FOV: 45 degrees; image size 2352x1568 — 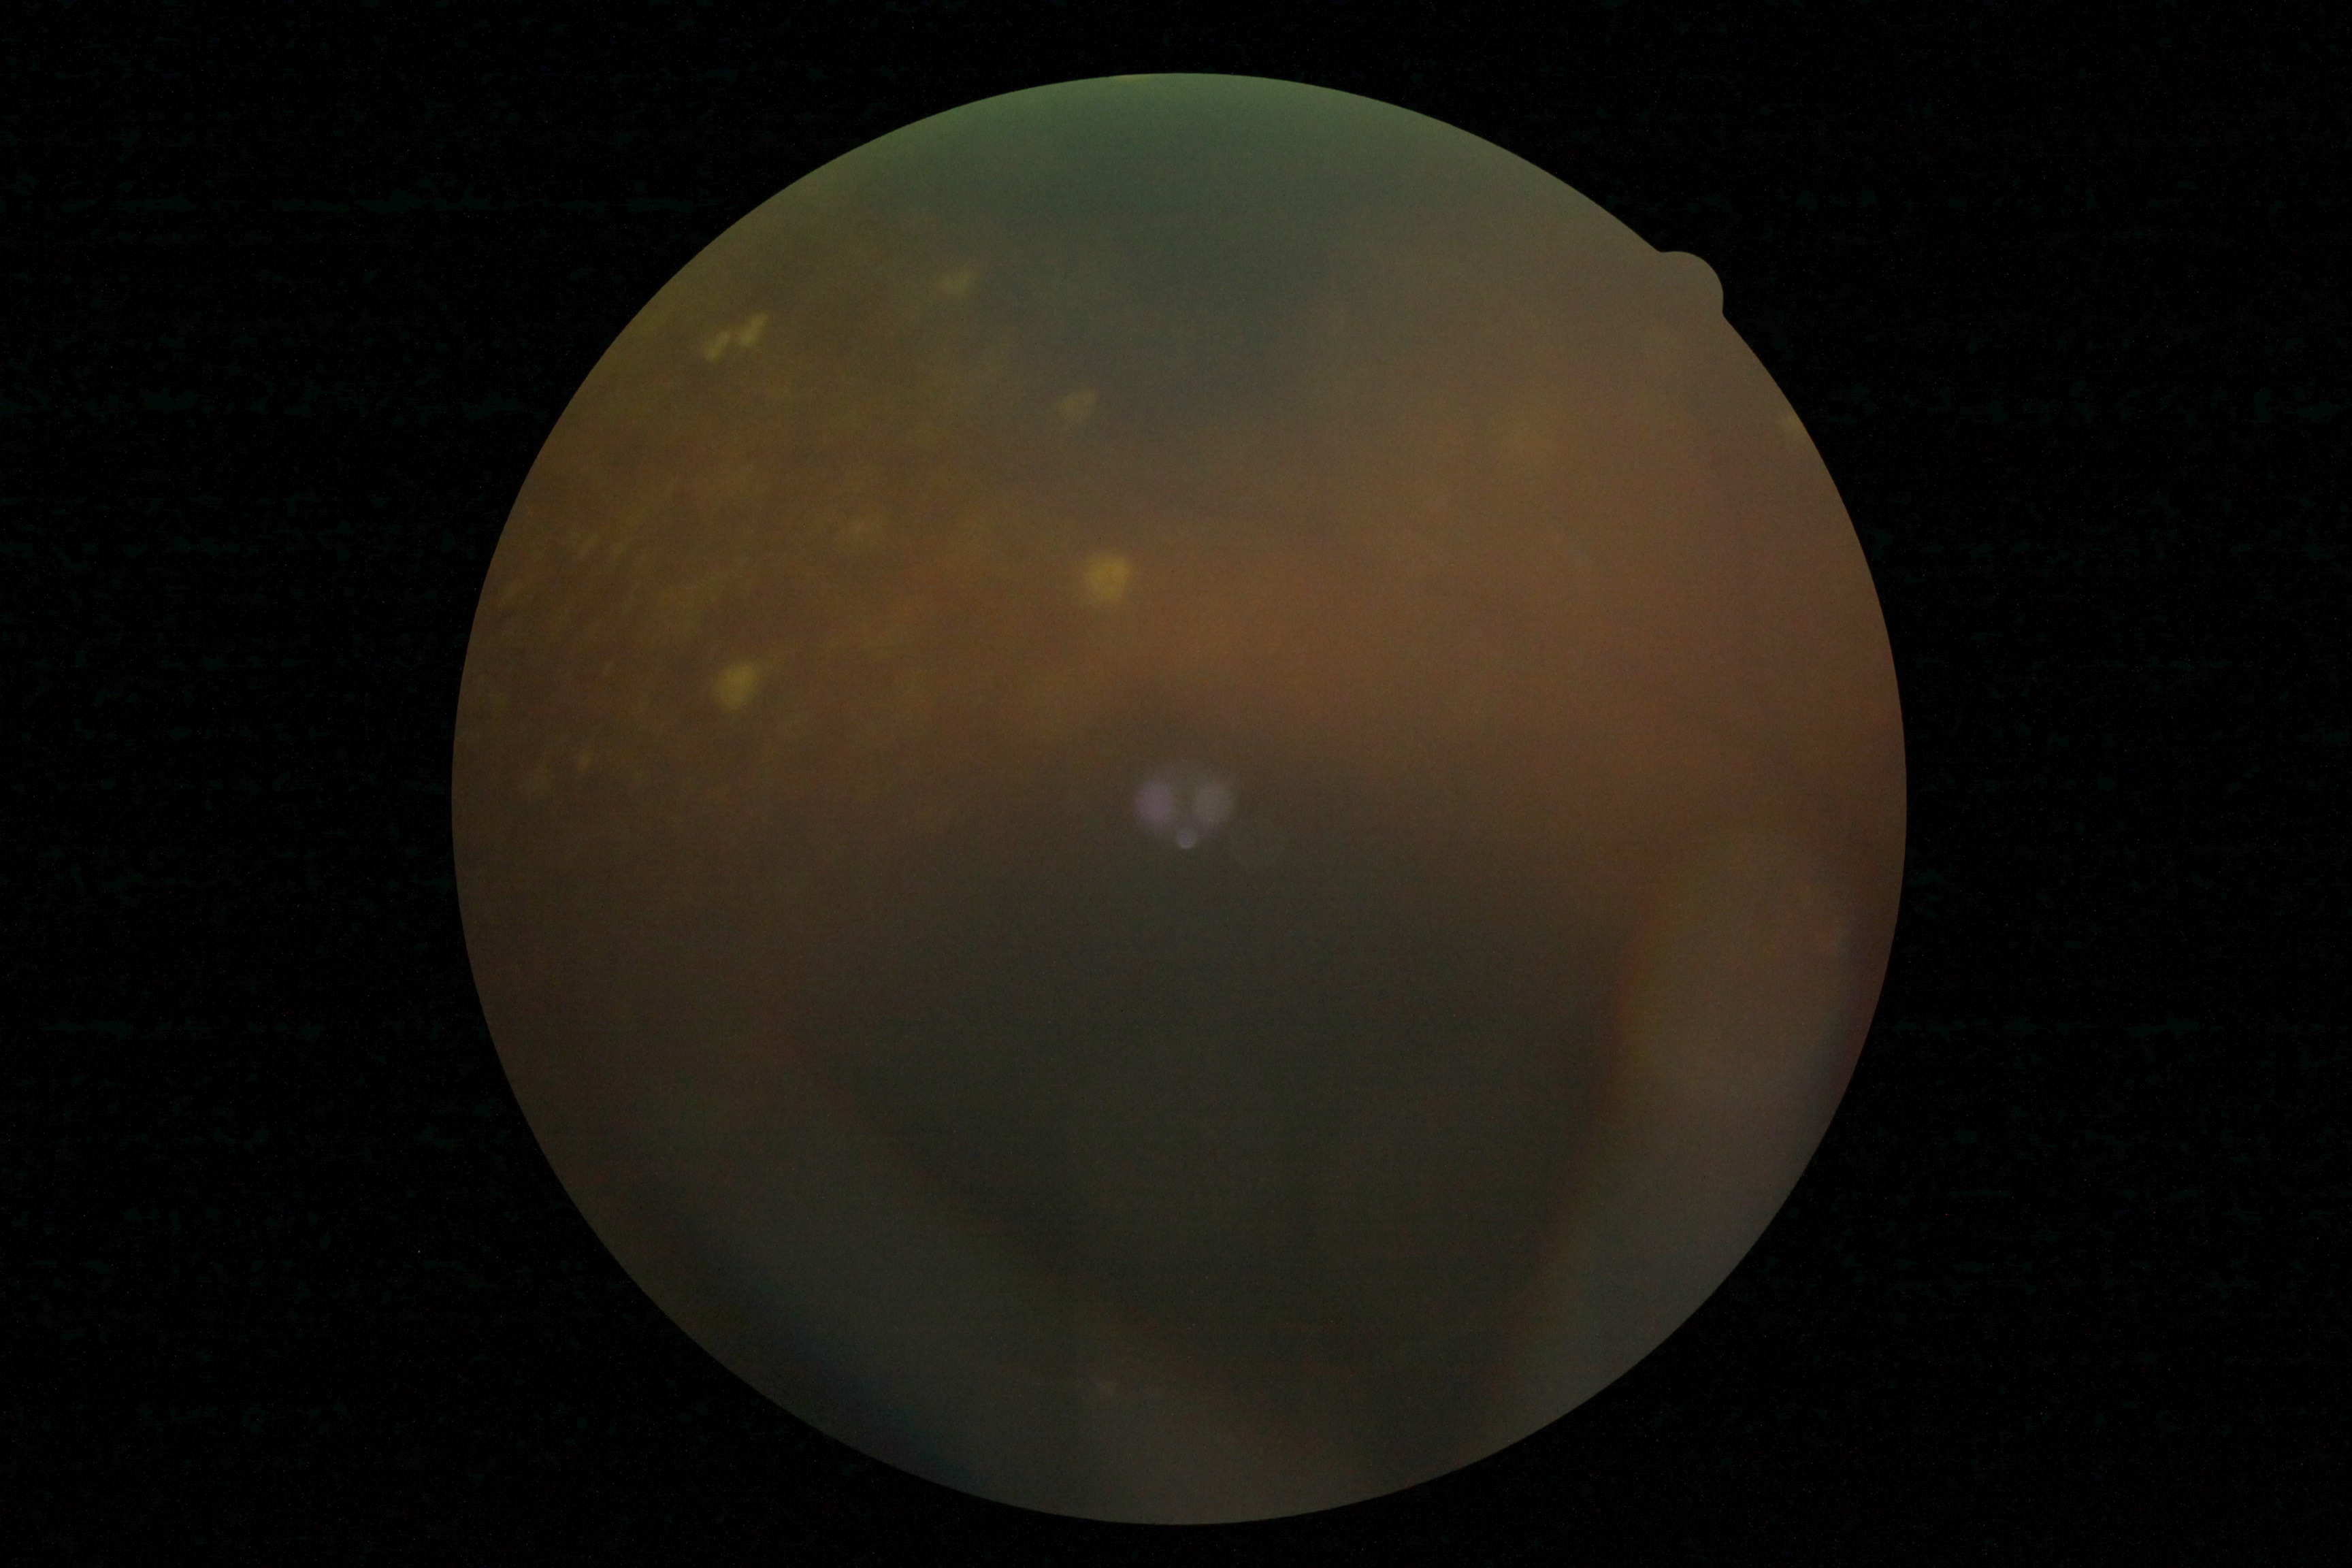

Diabetic retinopathy (DR) is ungradable.
Quality too poor to assess for DR.